Pediatric retinal photograph (wide-field); captured with the Phoenix ICON (100° field of view) — 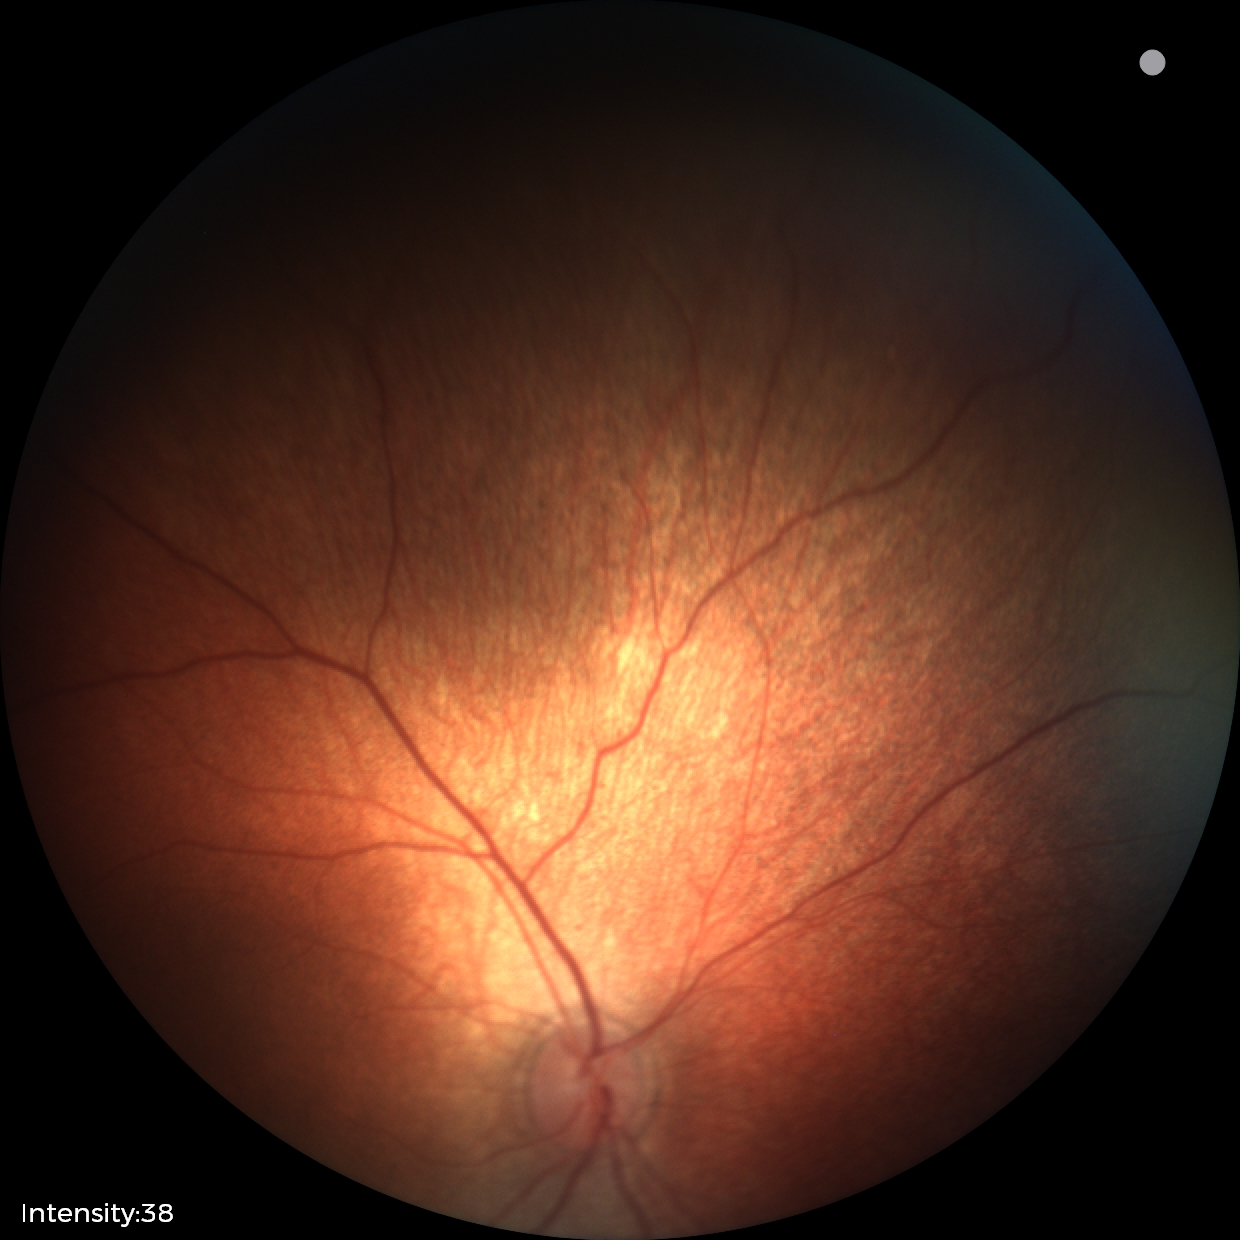

No retinal pathology identified on screening.